Image size 848x848:
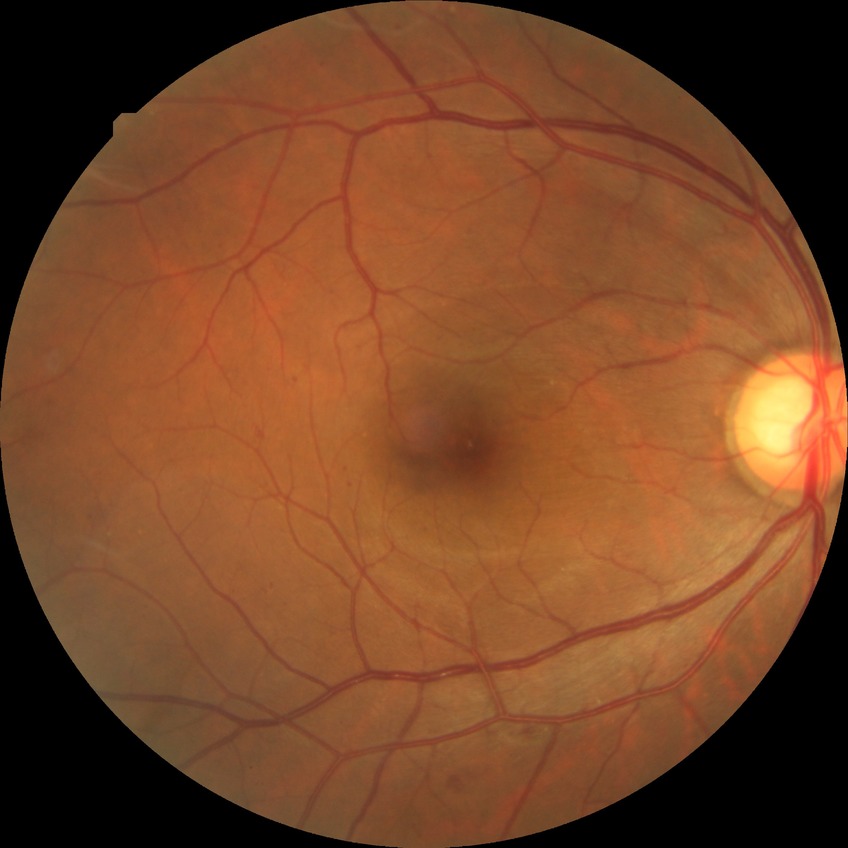 Disease class: non-proliferative diabetic retinopathy.
Diabetic retinopathy (DR): SDR (simple diabetic retinopathy).